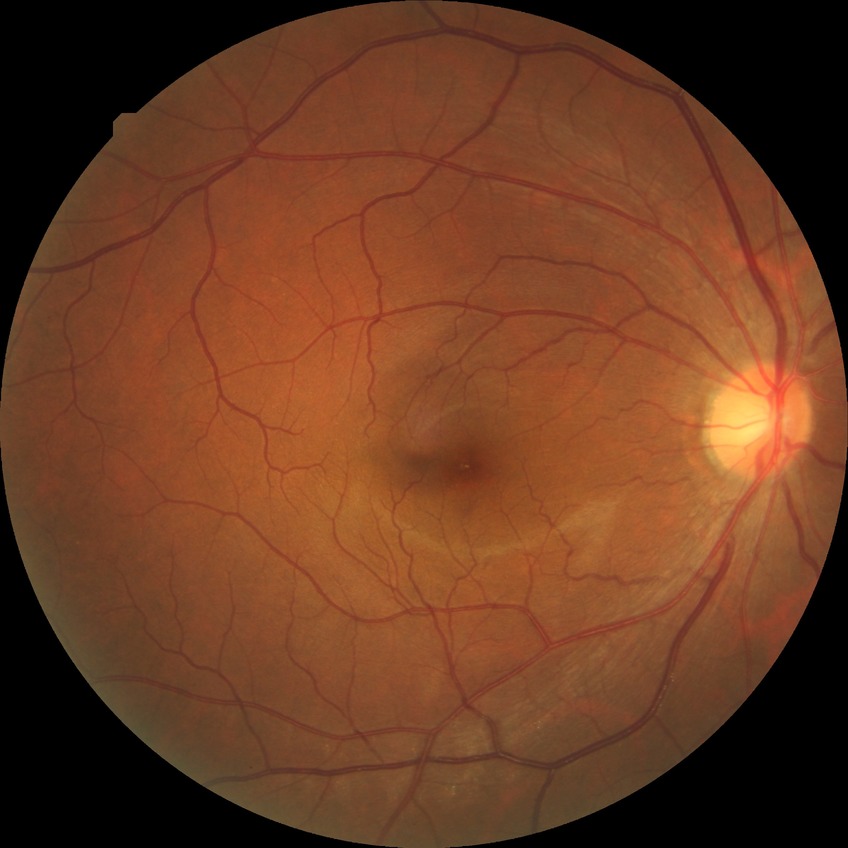

Davis grading: simple diabetic retinopathy | DR class: non-proliferative diabetic retinopathy.